Retinal fundus photograph
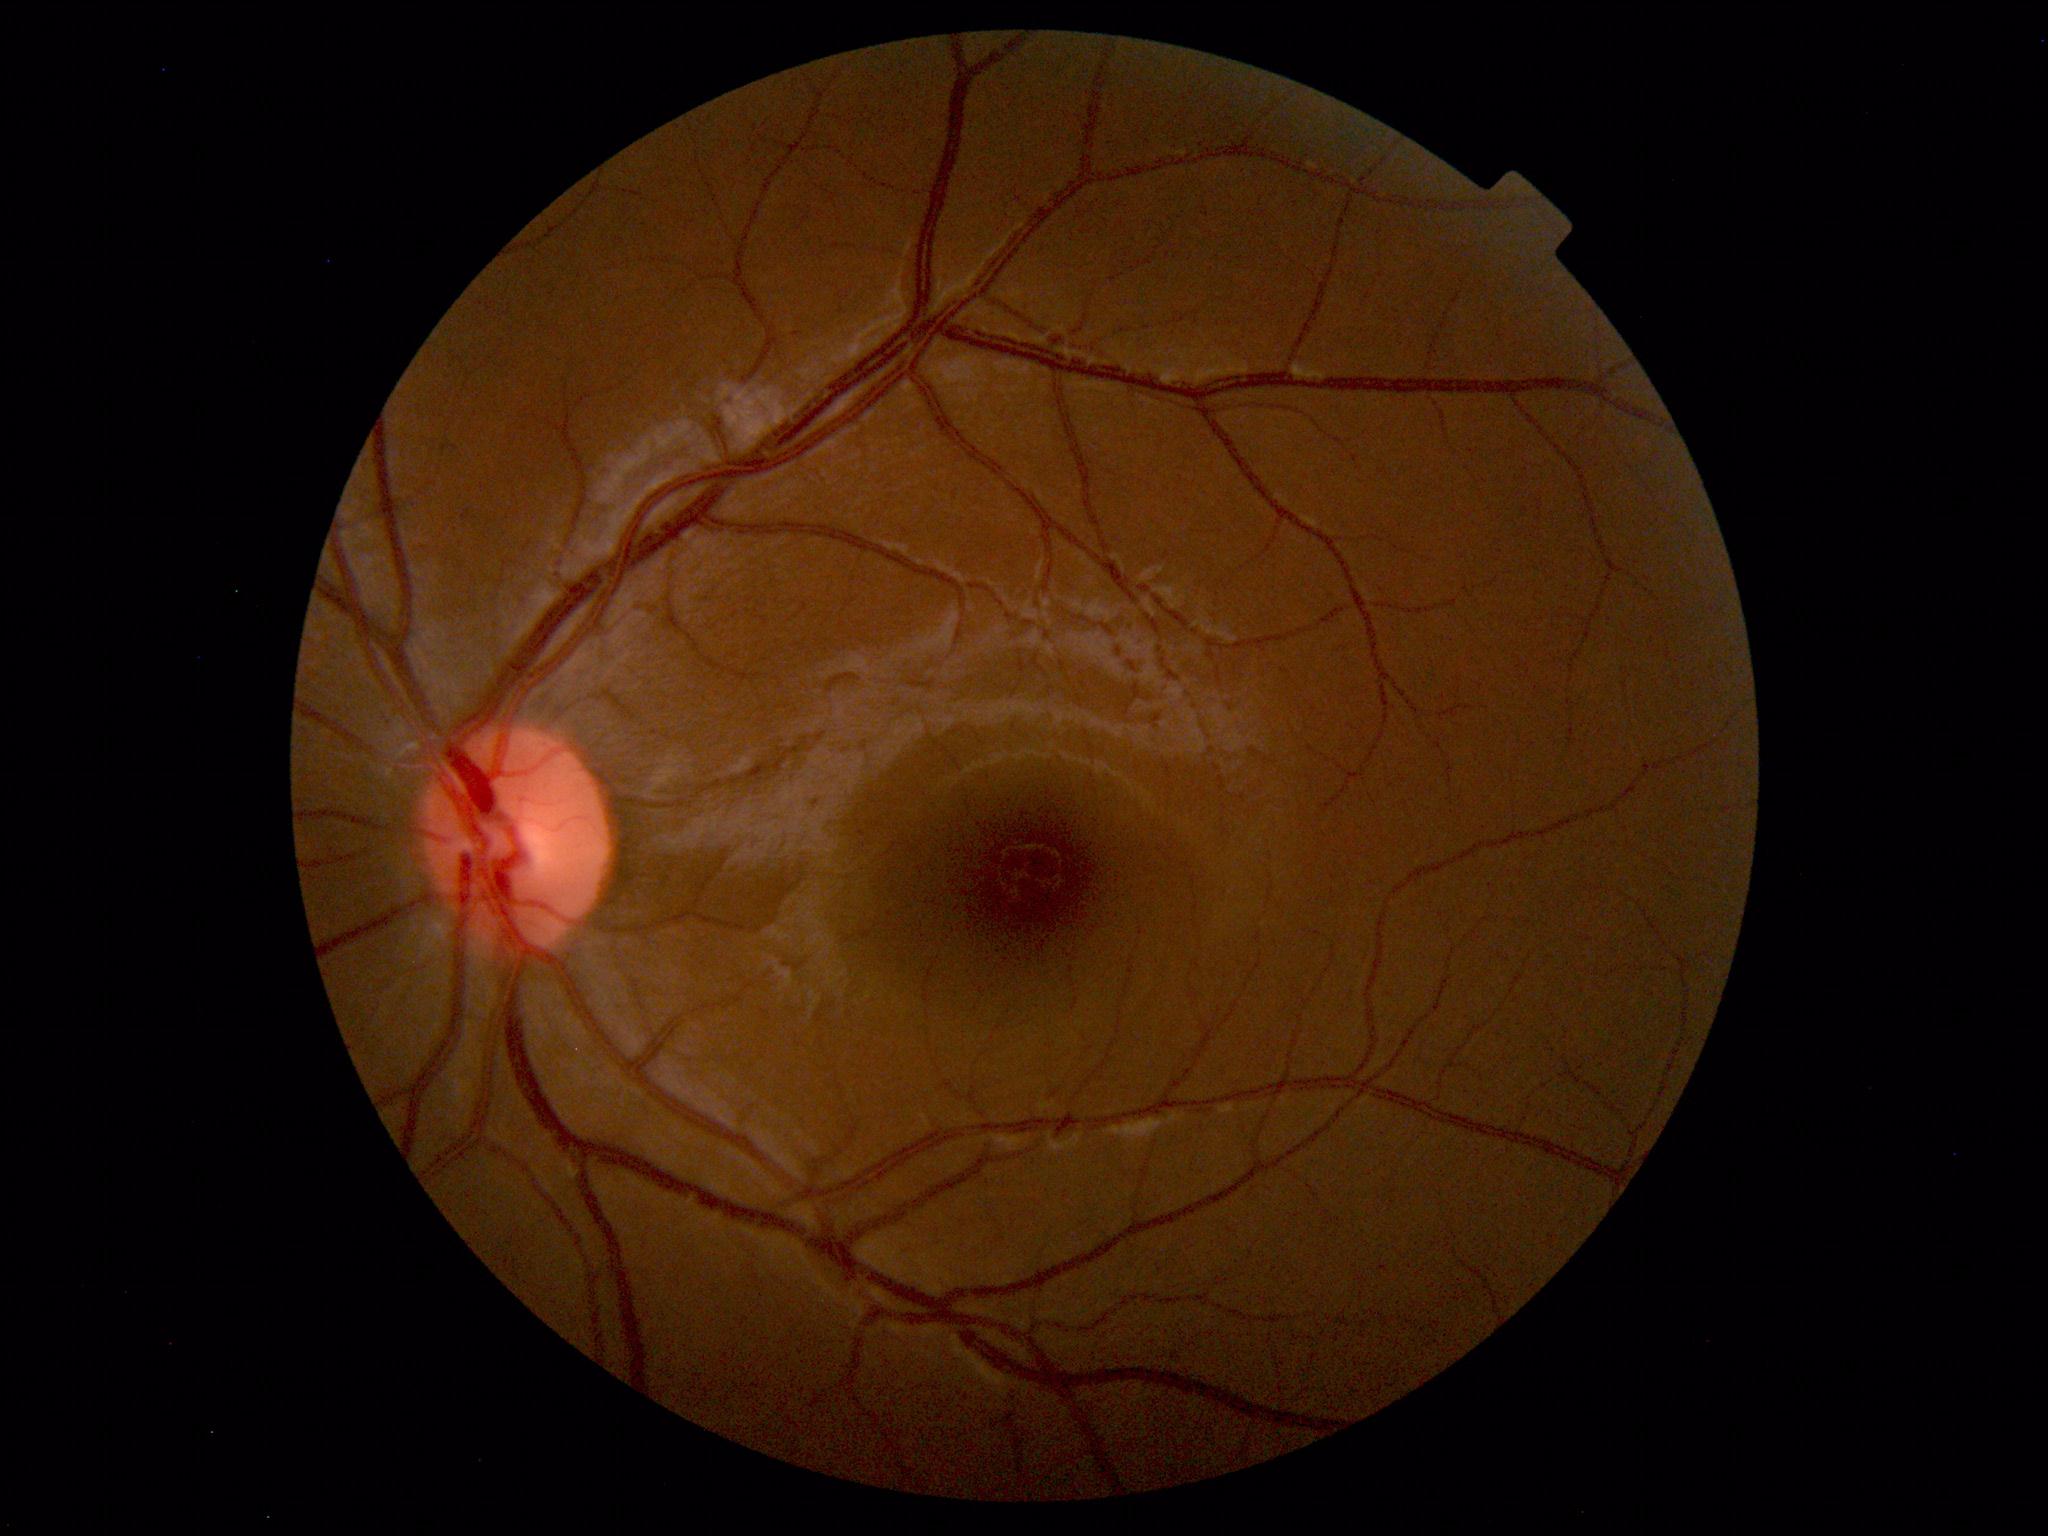
Findings: no abnormalities.